2352x1568:
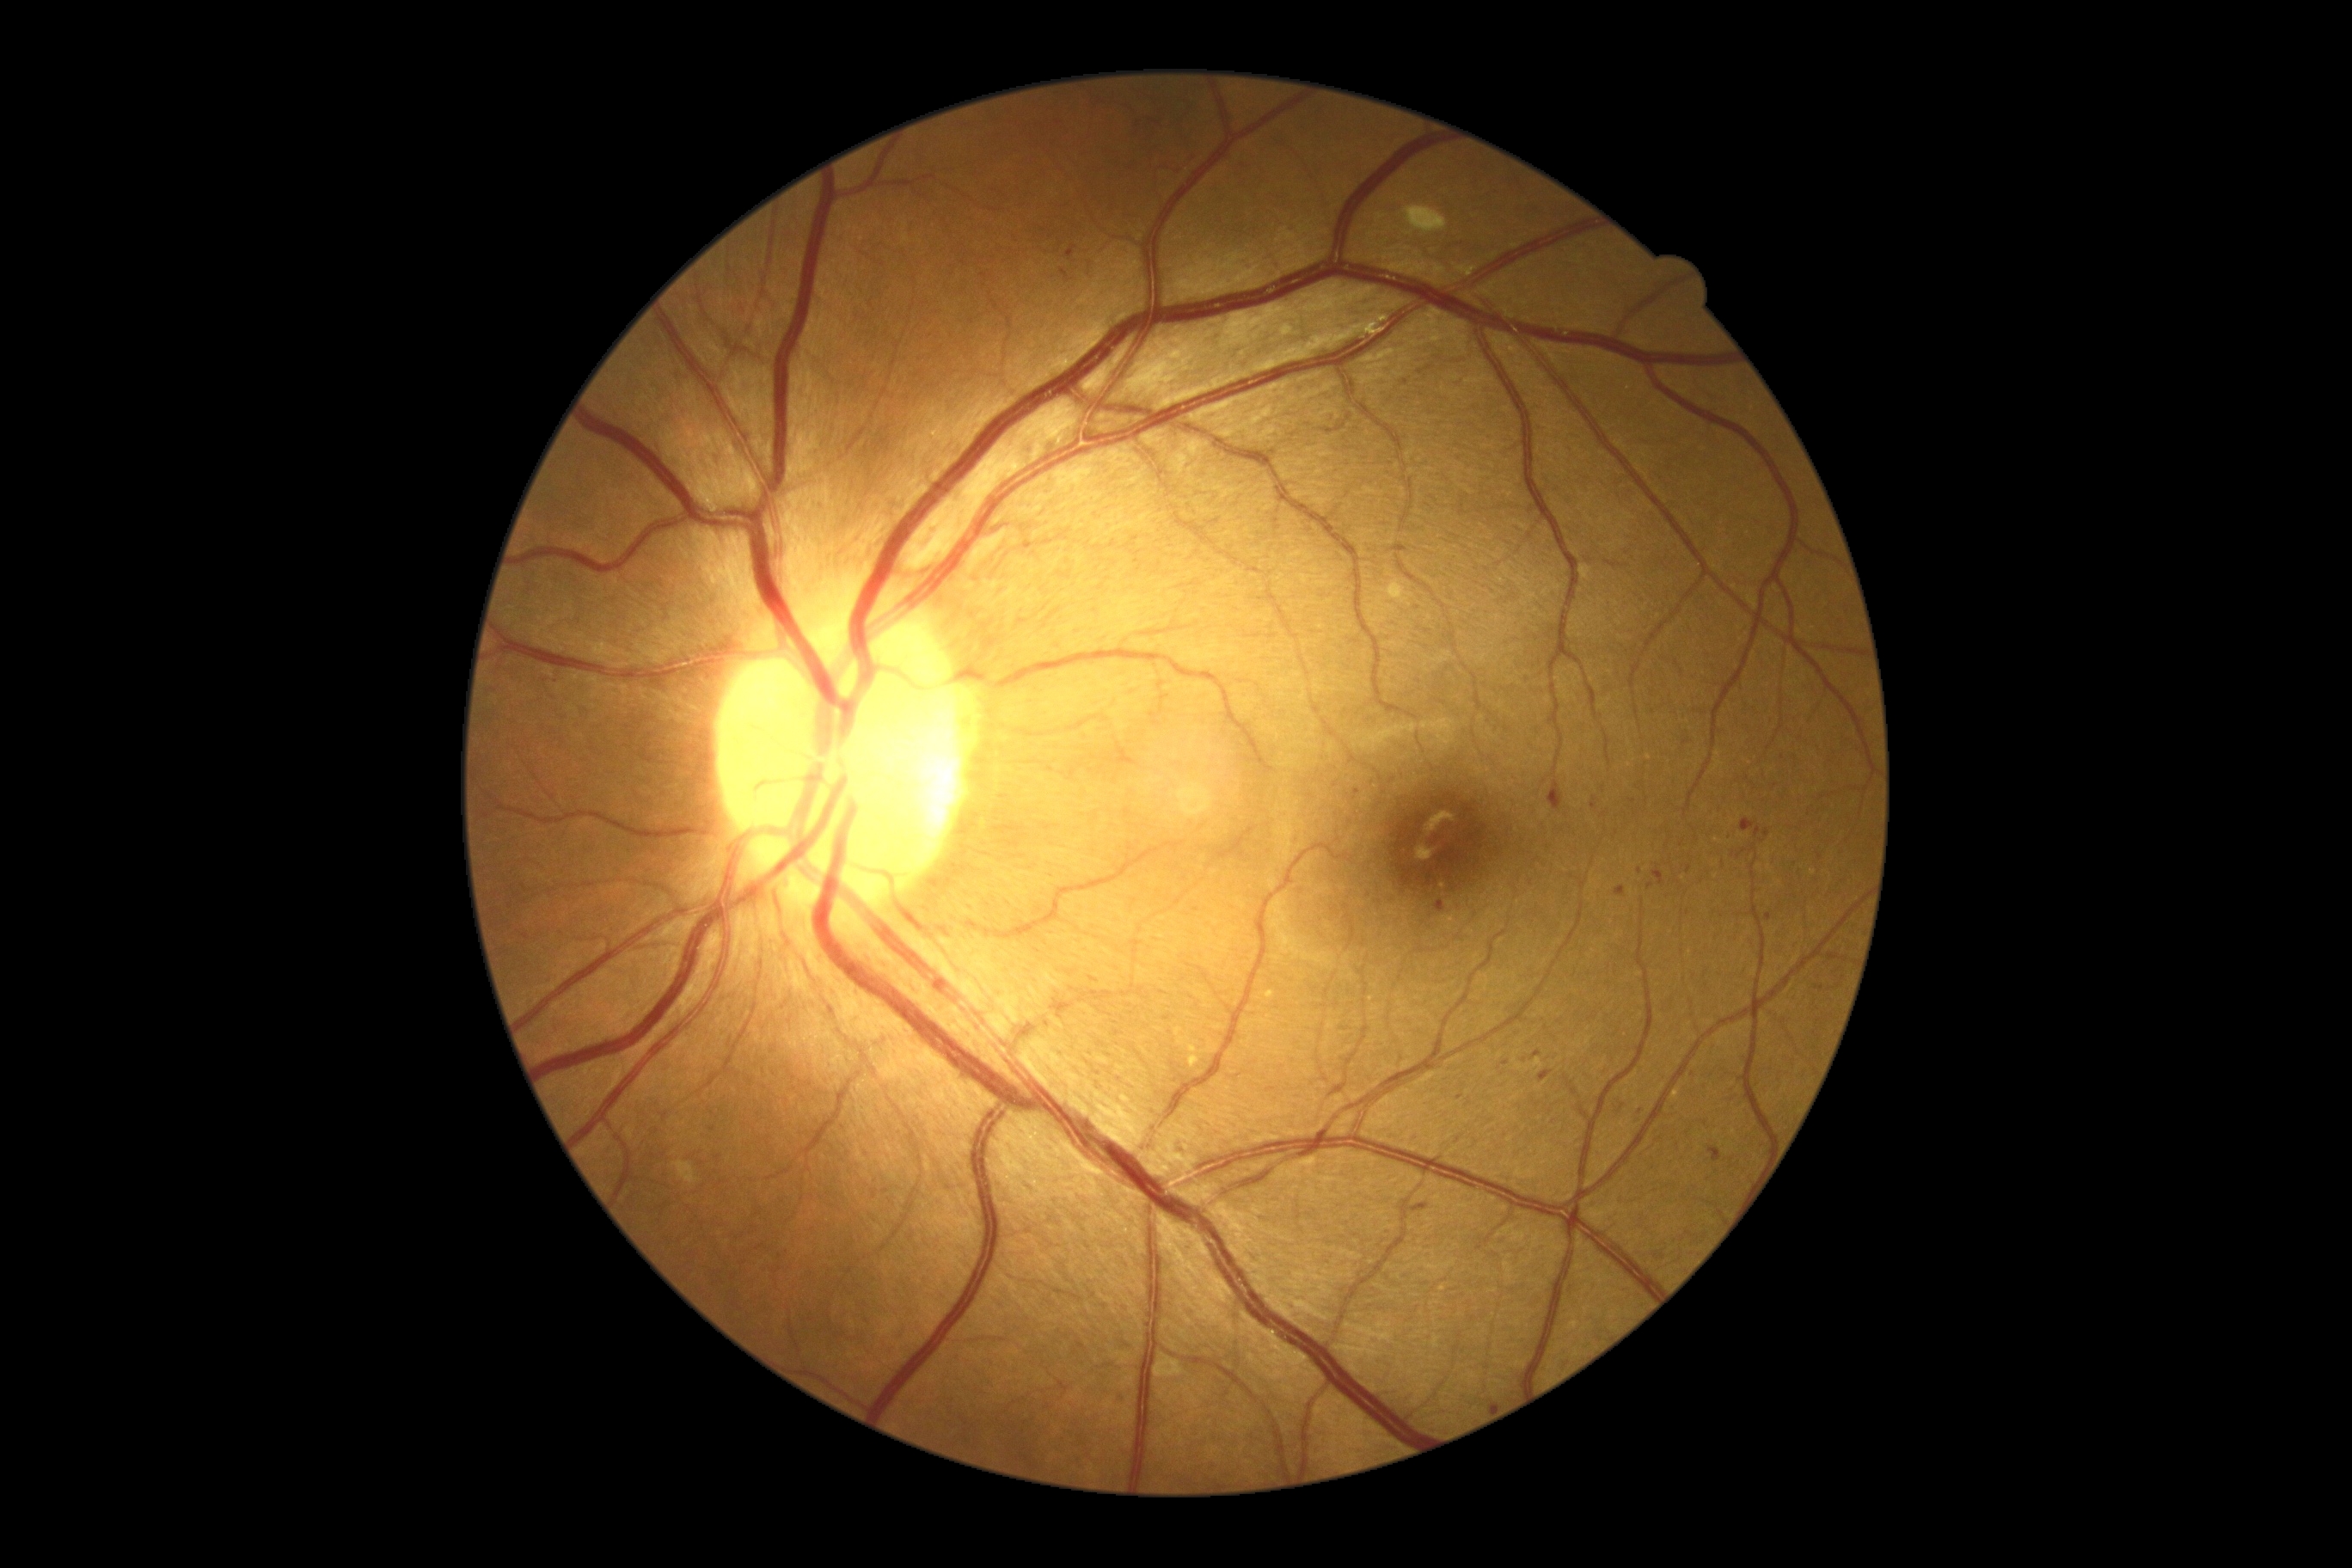
{"partial":true,"dr_grade":2,"dr_grade_name":"moderate NPDR","lesions":{"ma":null,"ex":[[1672,1089,1682,1099],[1187,1039,1201,1069],[1263,991,1277,1000]],"ex_small_approx":[[1813,873],[1629,389]],"se":null,"he":[[1354,790,1361,800],[1653,866,1667,886],[541,675,560,687],[1533,1051,1543,1060],[1112,1393,1125,1406],[1708,1148,1722,1163],[1548,780,1564,812],[1725,833,1732,842],[1737,848,1748,859],[1804,805,1816,818]],"he_small_approx":[[1782,757],[1428,632],[712,1130],[780,1256],[788,1251],[1761,841],[1649,886]]}}